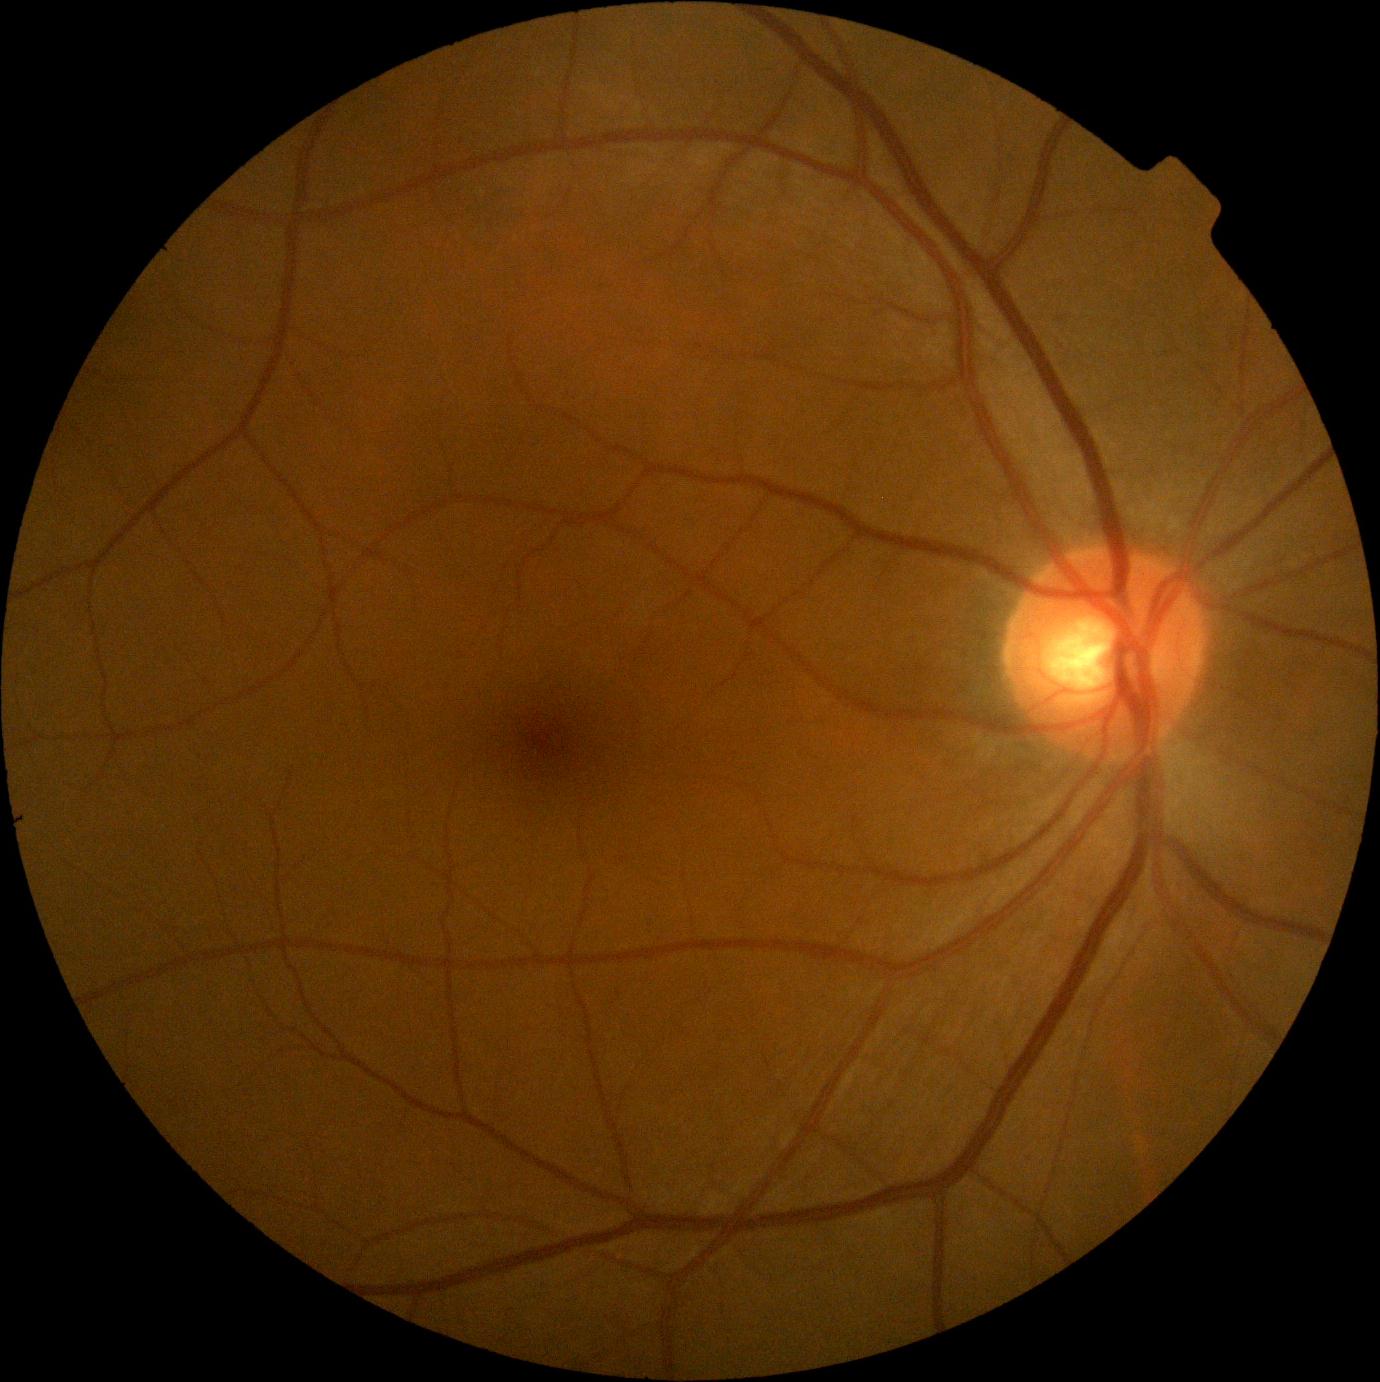

Diabetic retinopathy (DR) is no apparent diabetic retinopathy (grade 0).